Retinal fundus photograph
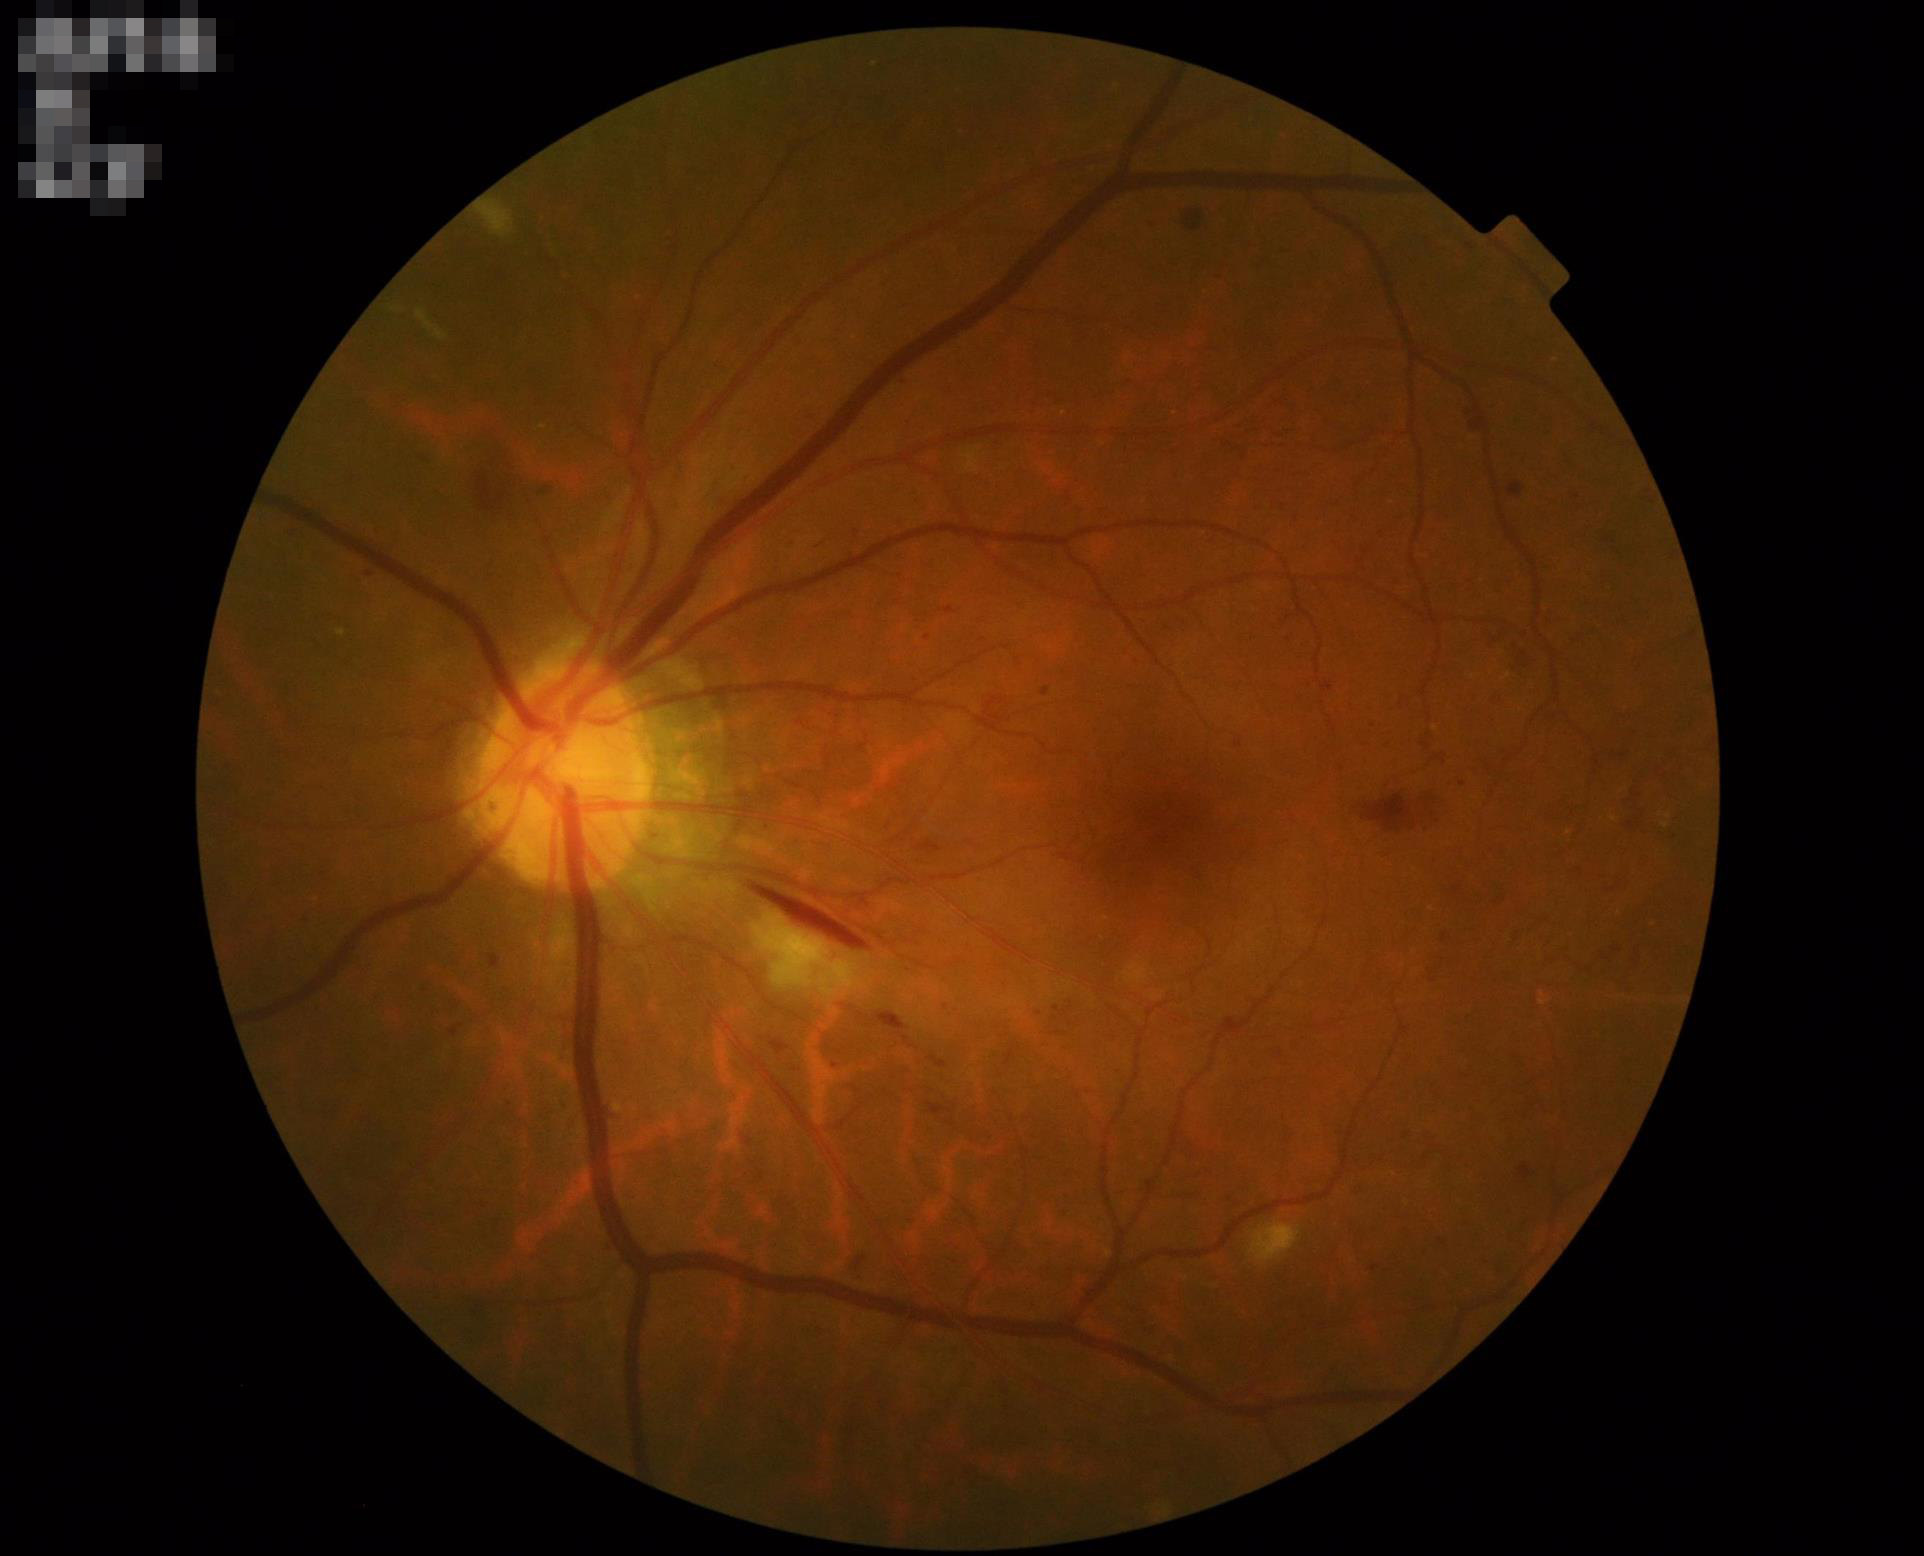

Illumination is even.
Image is sharp throughout the field.
Acceptable image quality.
Vessels and details are readily distinguishable.